Phoenix ICON wide-field infant fundus image · 1240x1240:
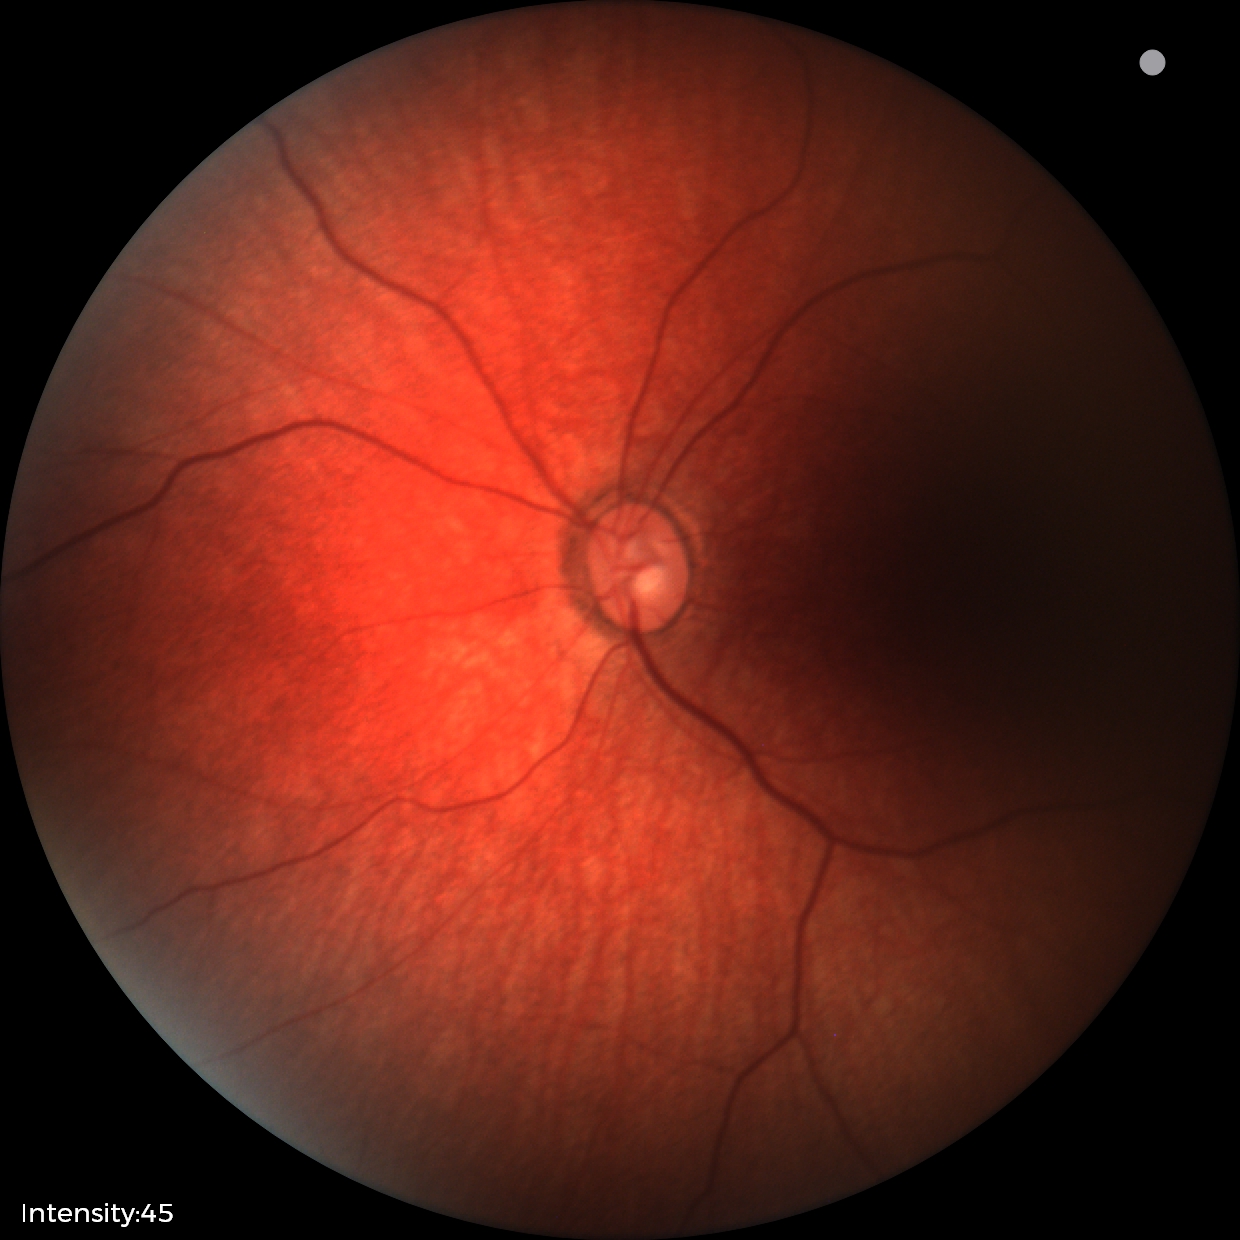 Screening examination with no abnormal retinal findings.